Retinal fundus photograph. Diabetic retinopathy graded by the modified Davis classification
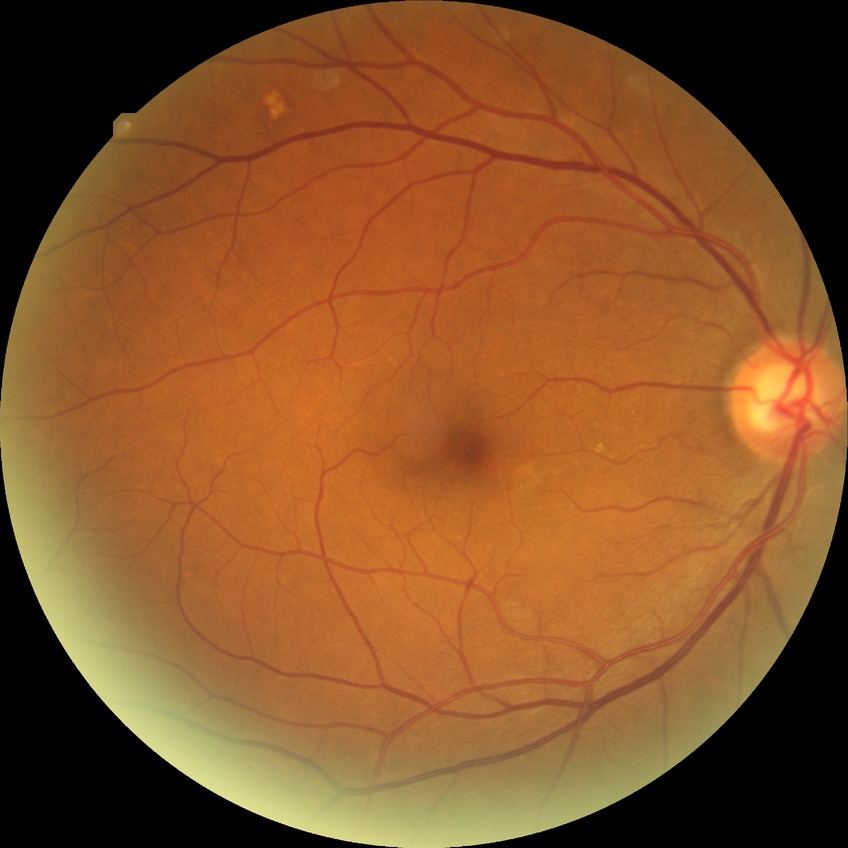 No signs of diabetic retinopathy. Davis DR grade is NDR.